Color fundus photograph:
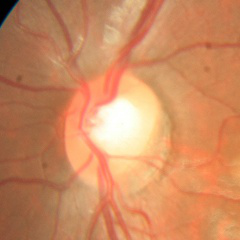 No glaucomatous changes.